2352x1568px, color fundus photograph: 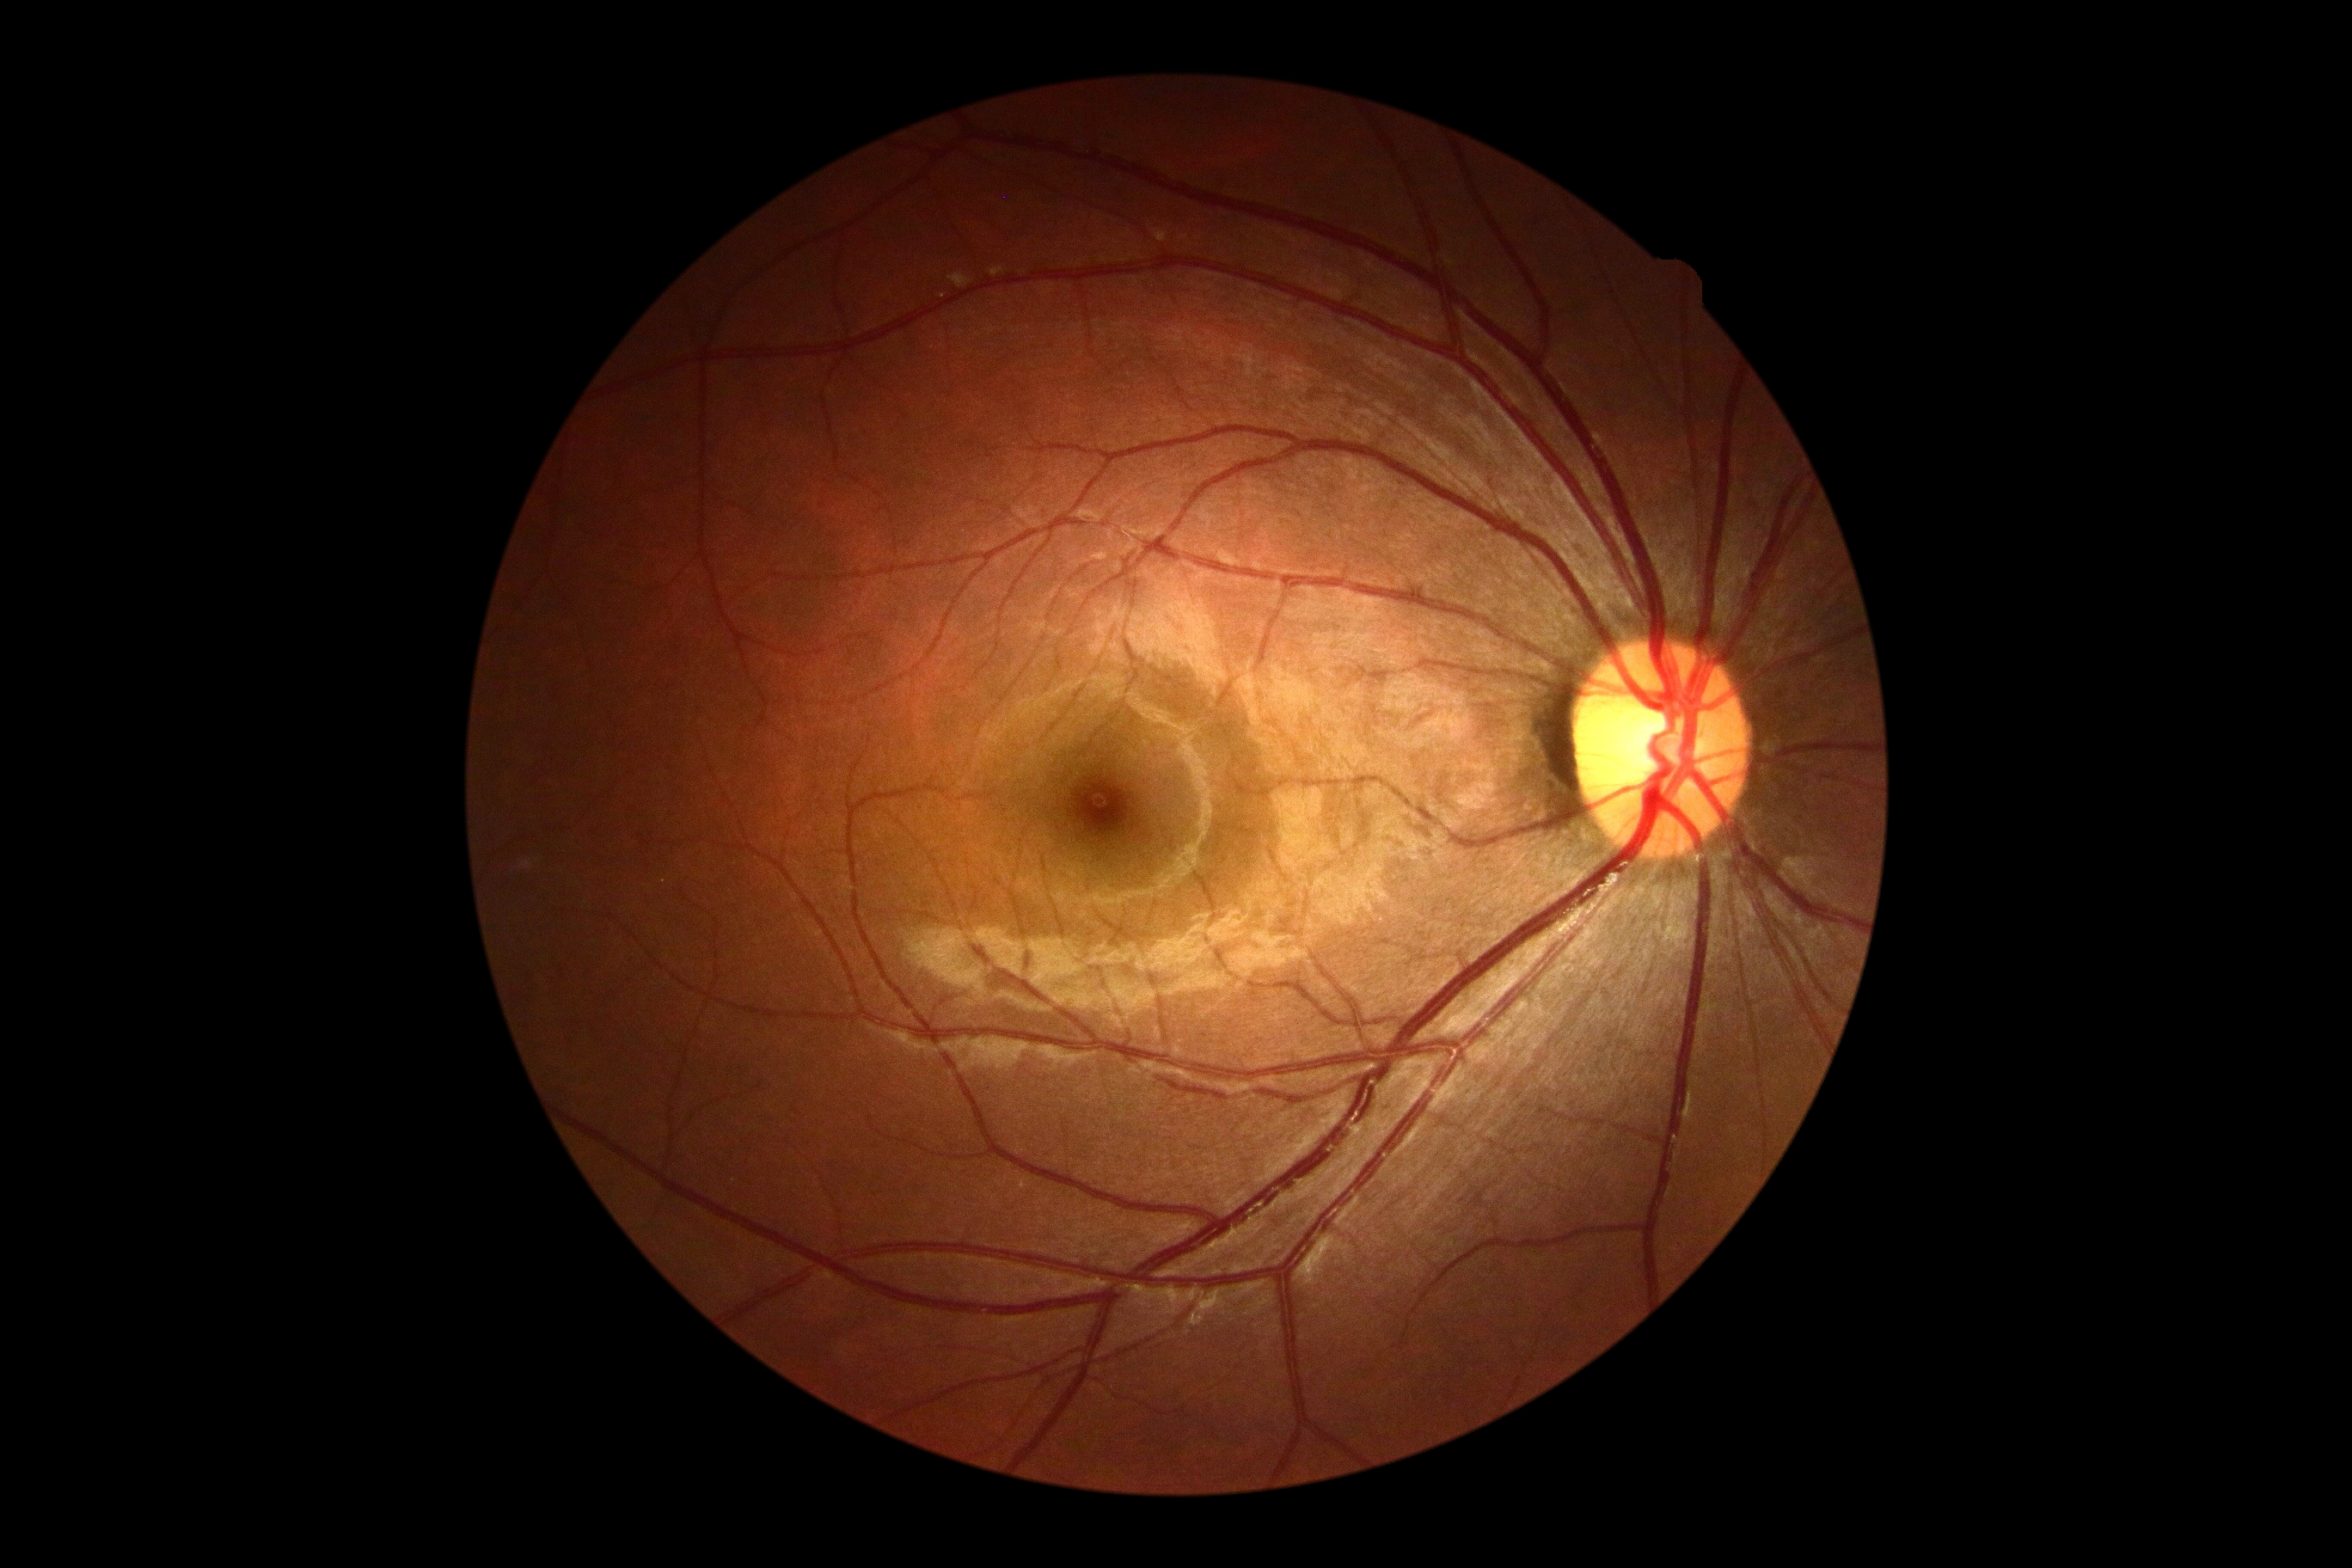 Diabetic retinopathy grade: 0 — no visible signs of diabetic retinopathy.